45° field of view — 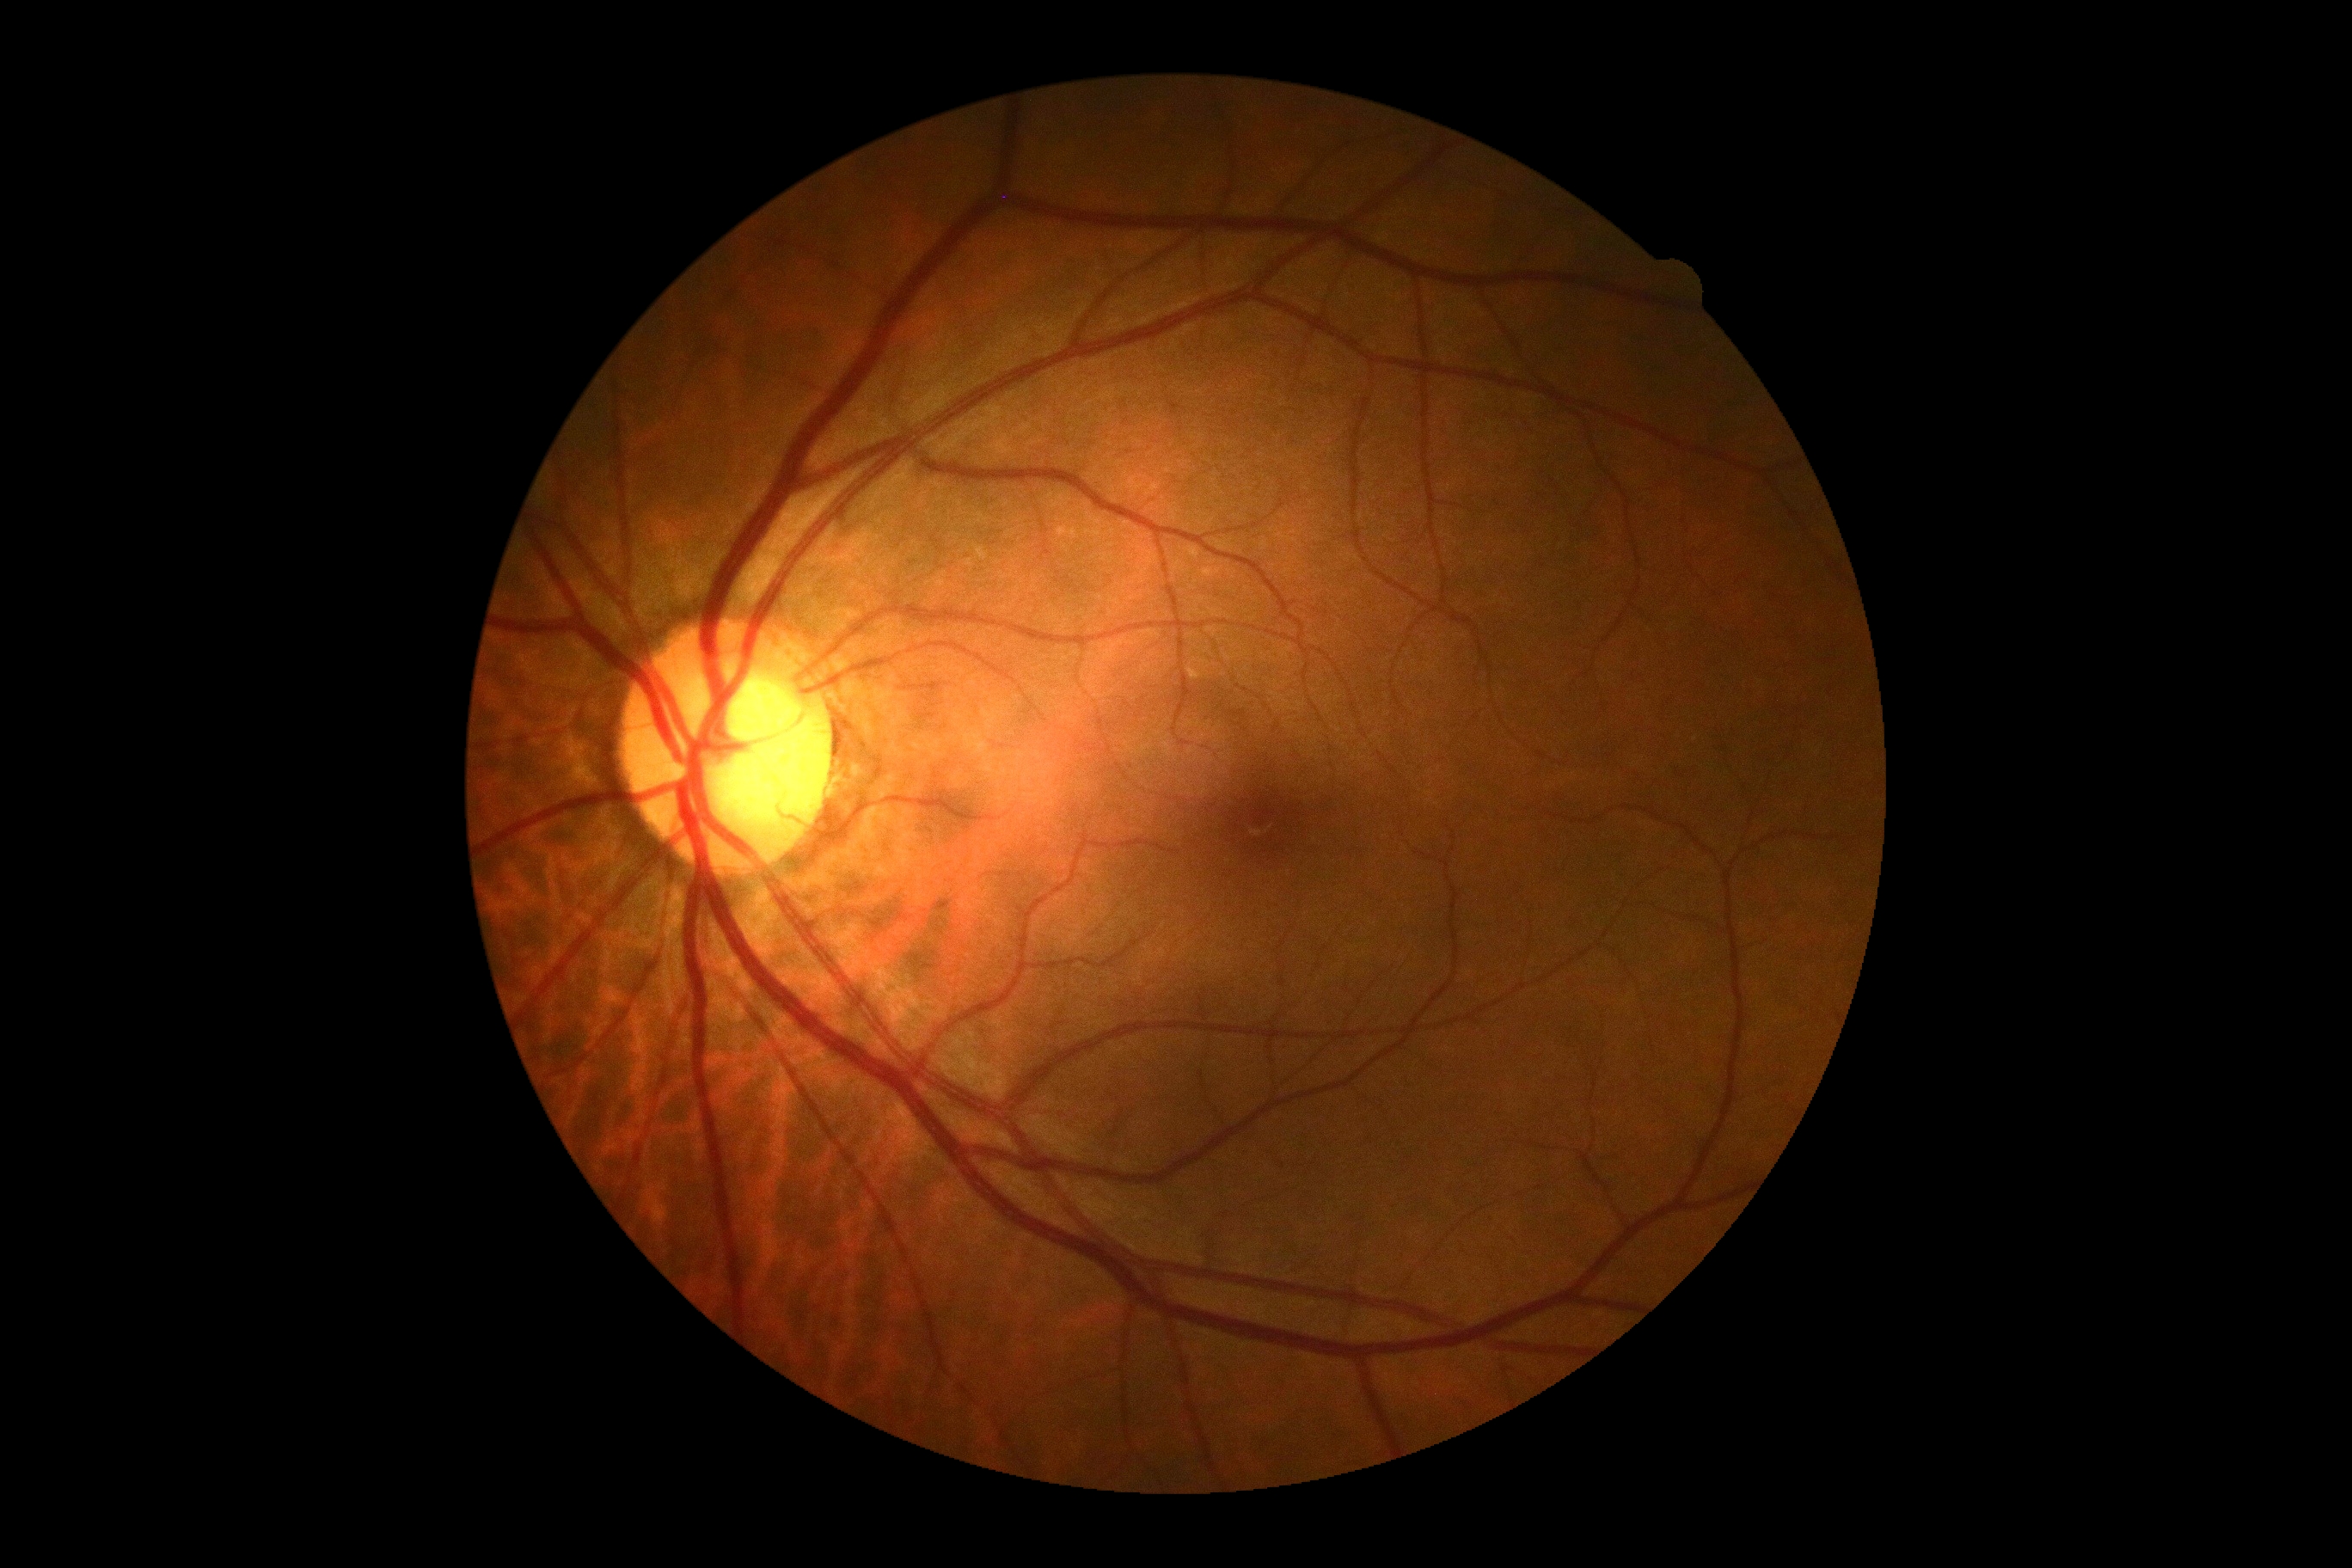

Annotations:
– DR stage: 0
– DR impression: no signs of DR